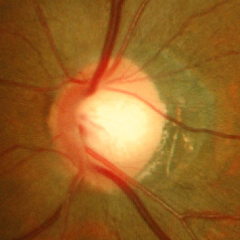
The image shows early glaucomatous changes.